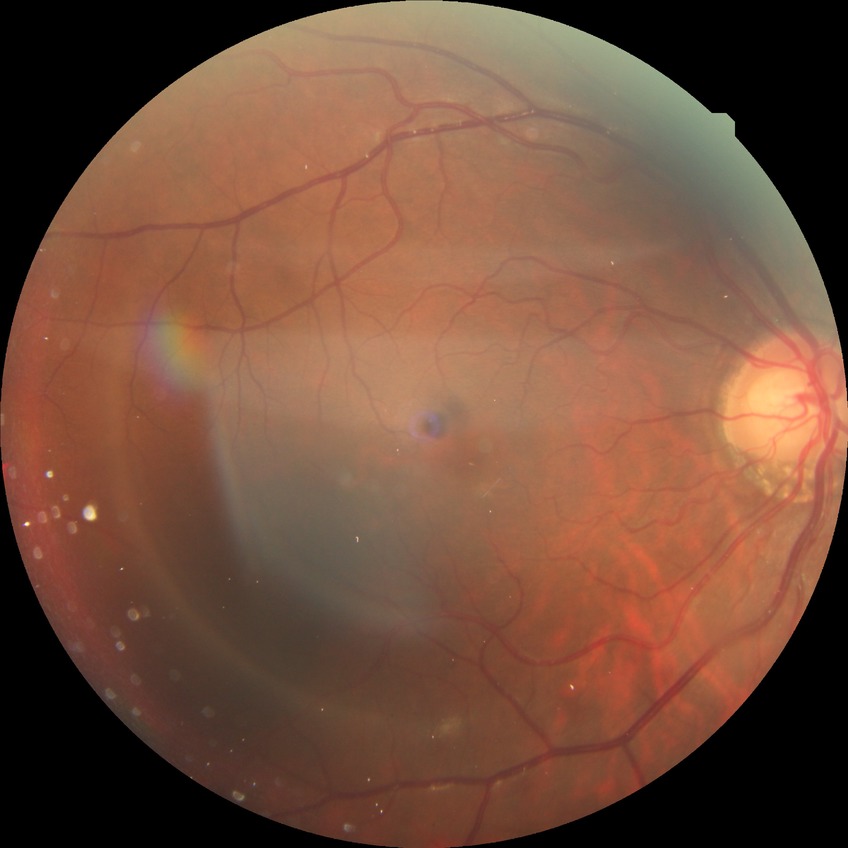   davis_grade: NDR
  dr_impression: no signs of DR